848 by 848 pixels. 45 degree fundus photograph. Nonmydriatic fundus photograph. Posterior pole color fundus photograph — 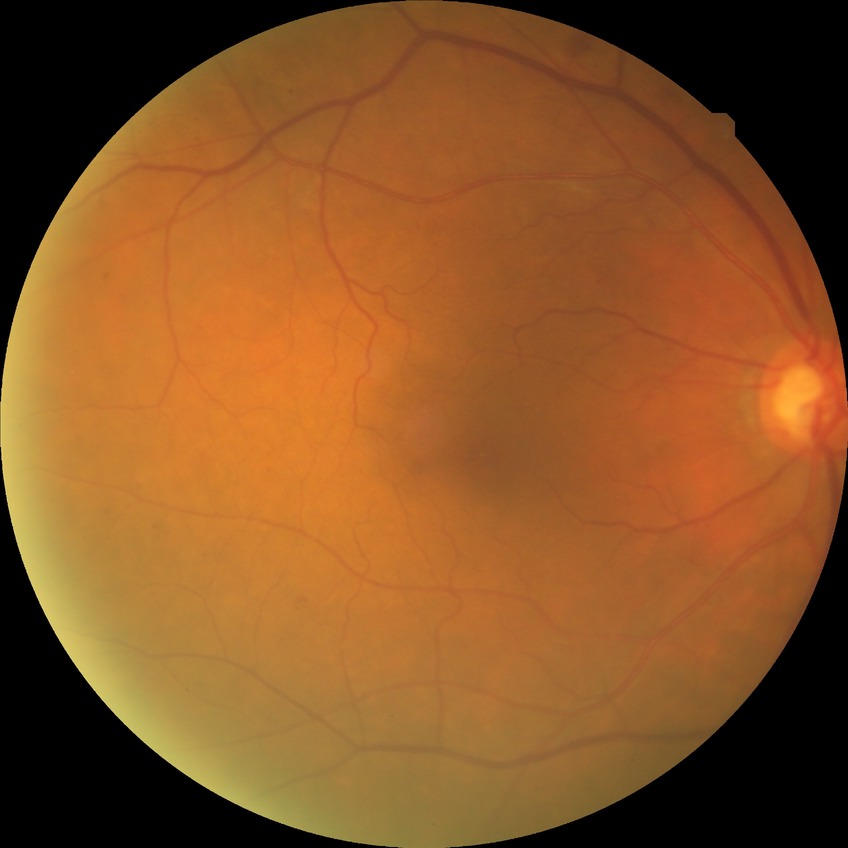

Davis grading is simple diabetic retinopathy. DR class: non-proliferative diabetic retinopathy.